Fundus photo:
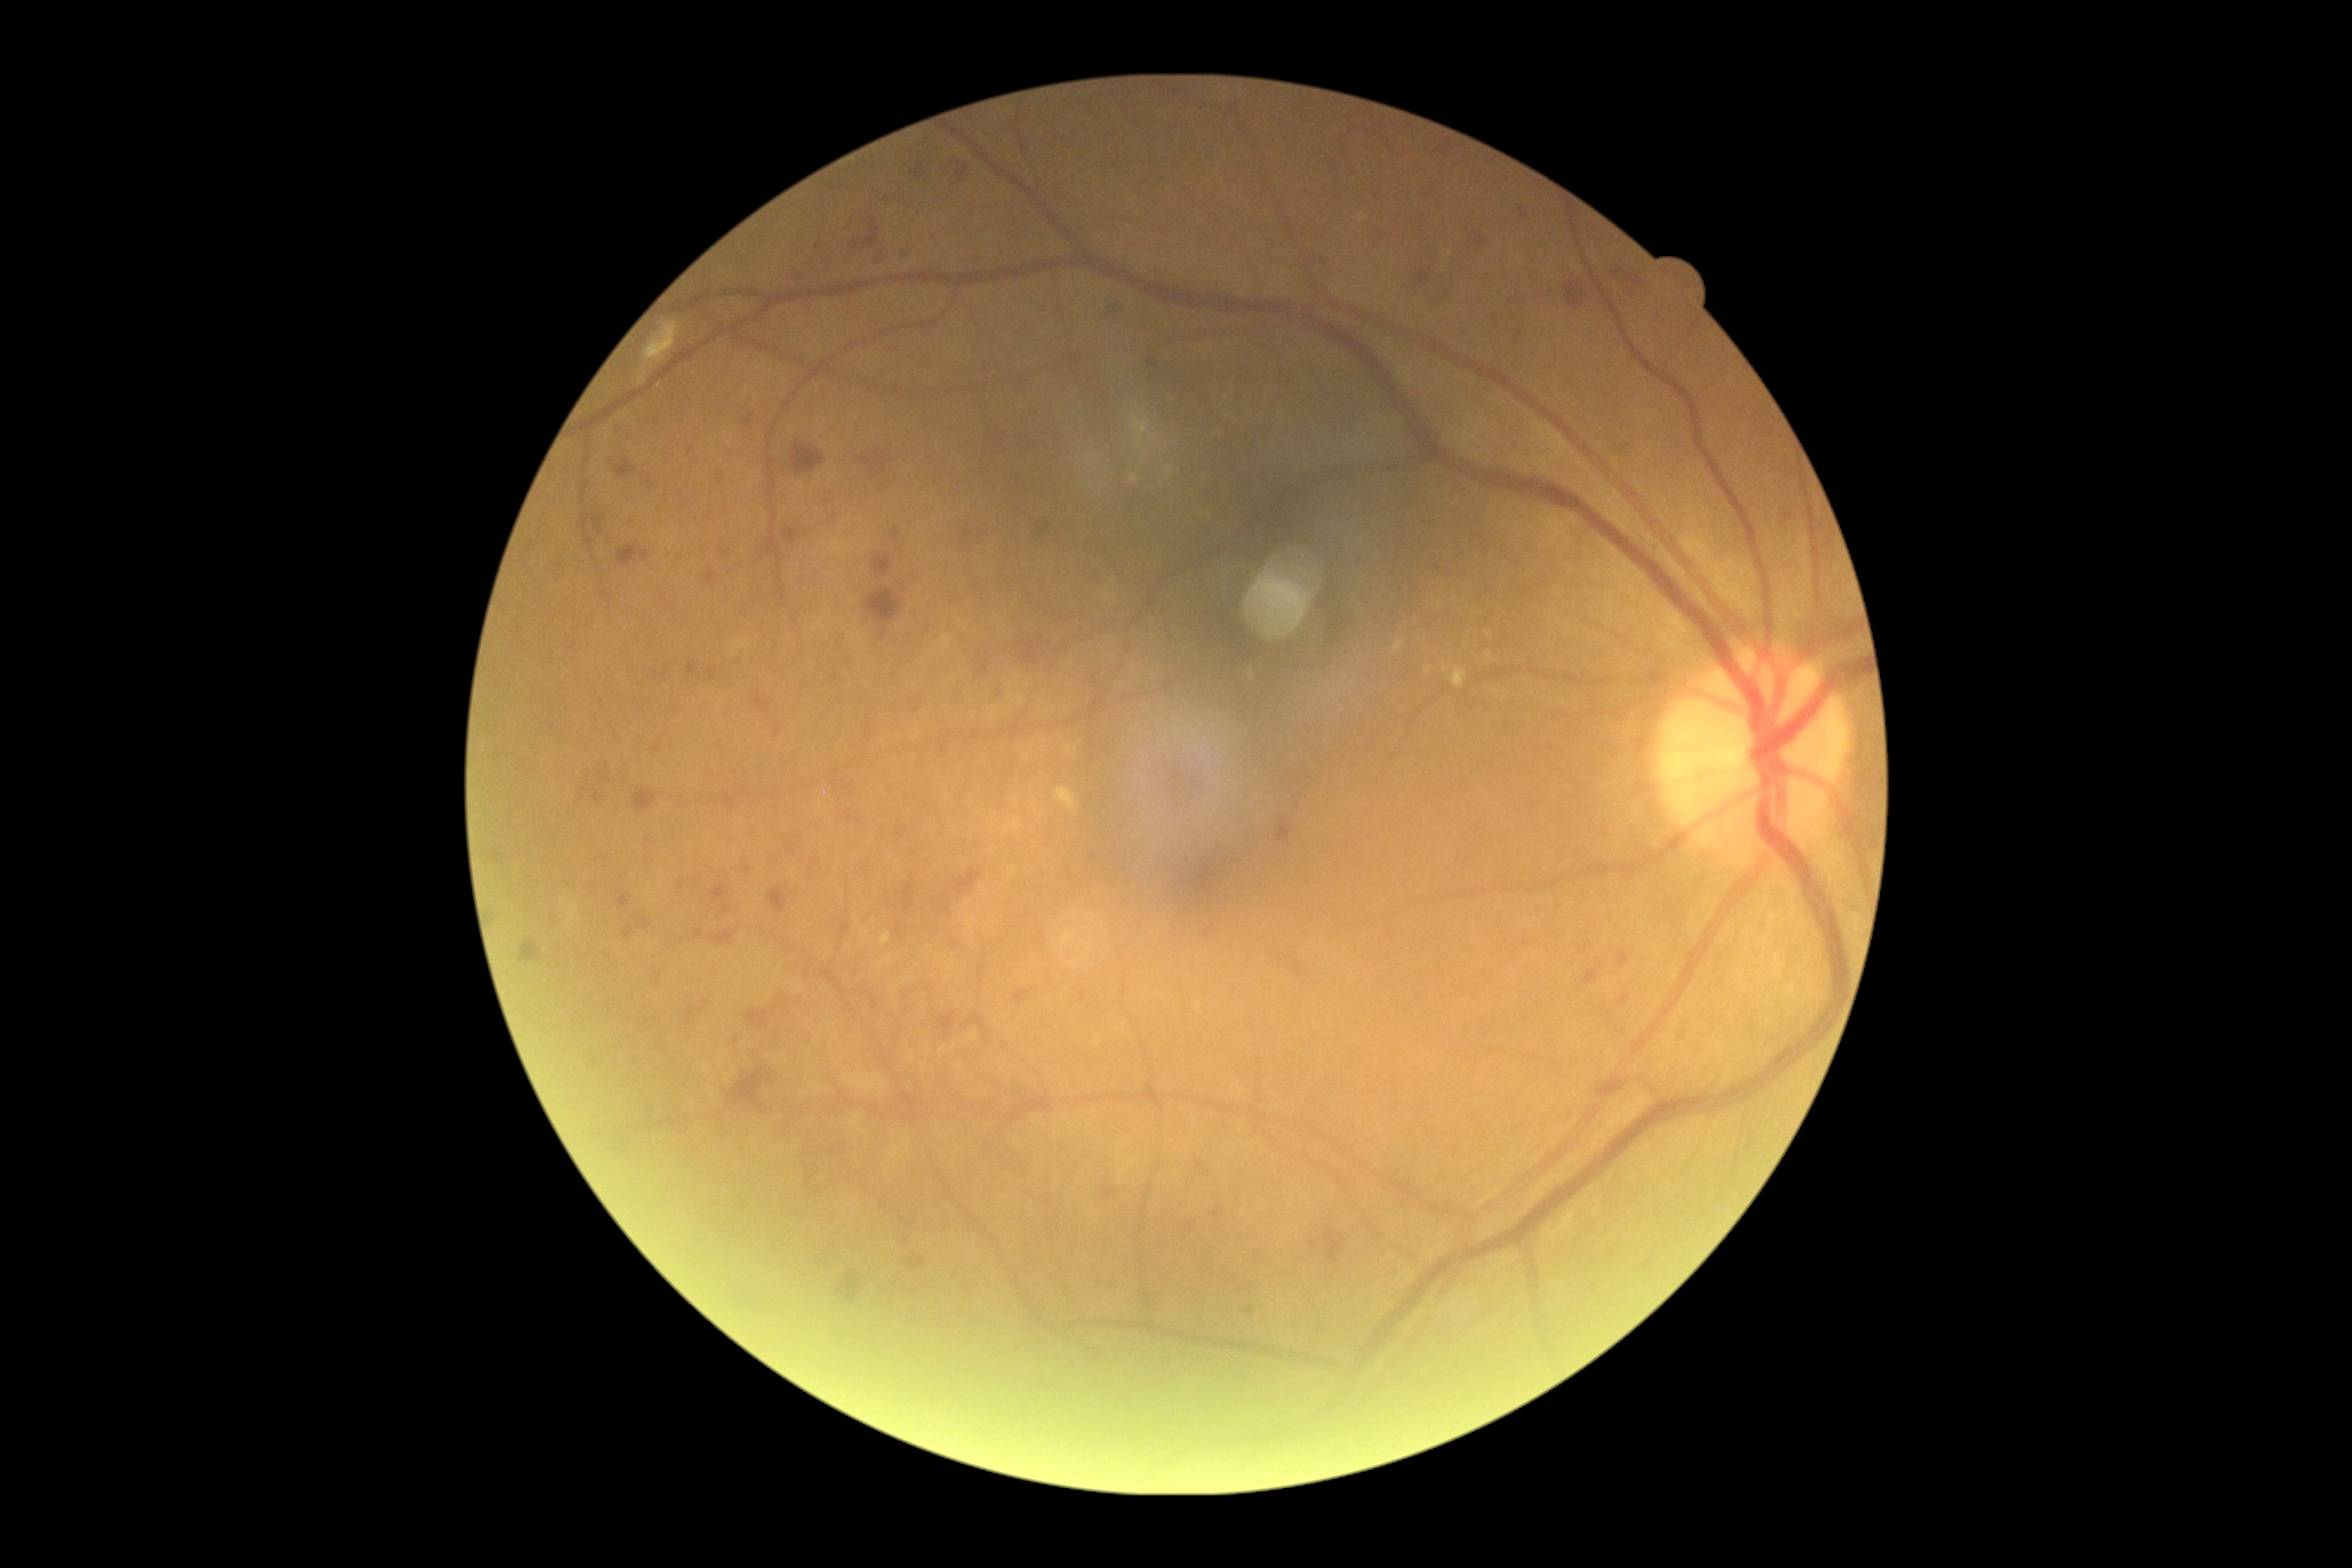
DR stage is severe non-proliferative diabetic retinopathy (grade 3).
Disease class: non-proliferative diabetic retinopathy.